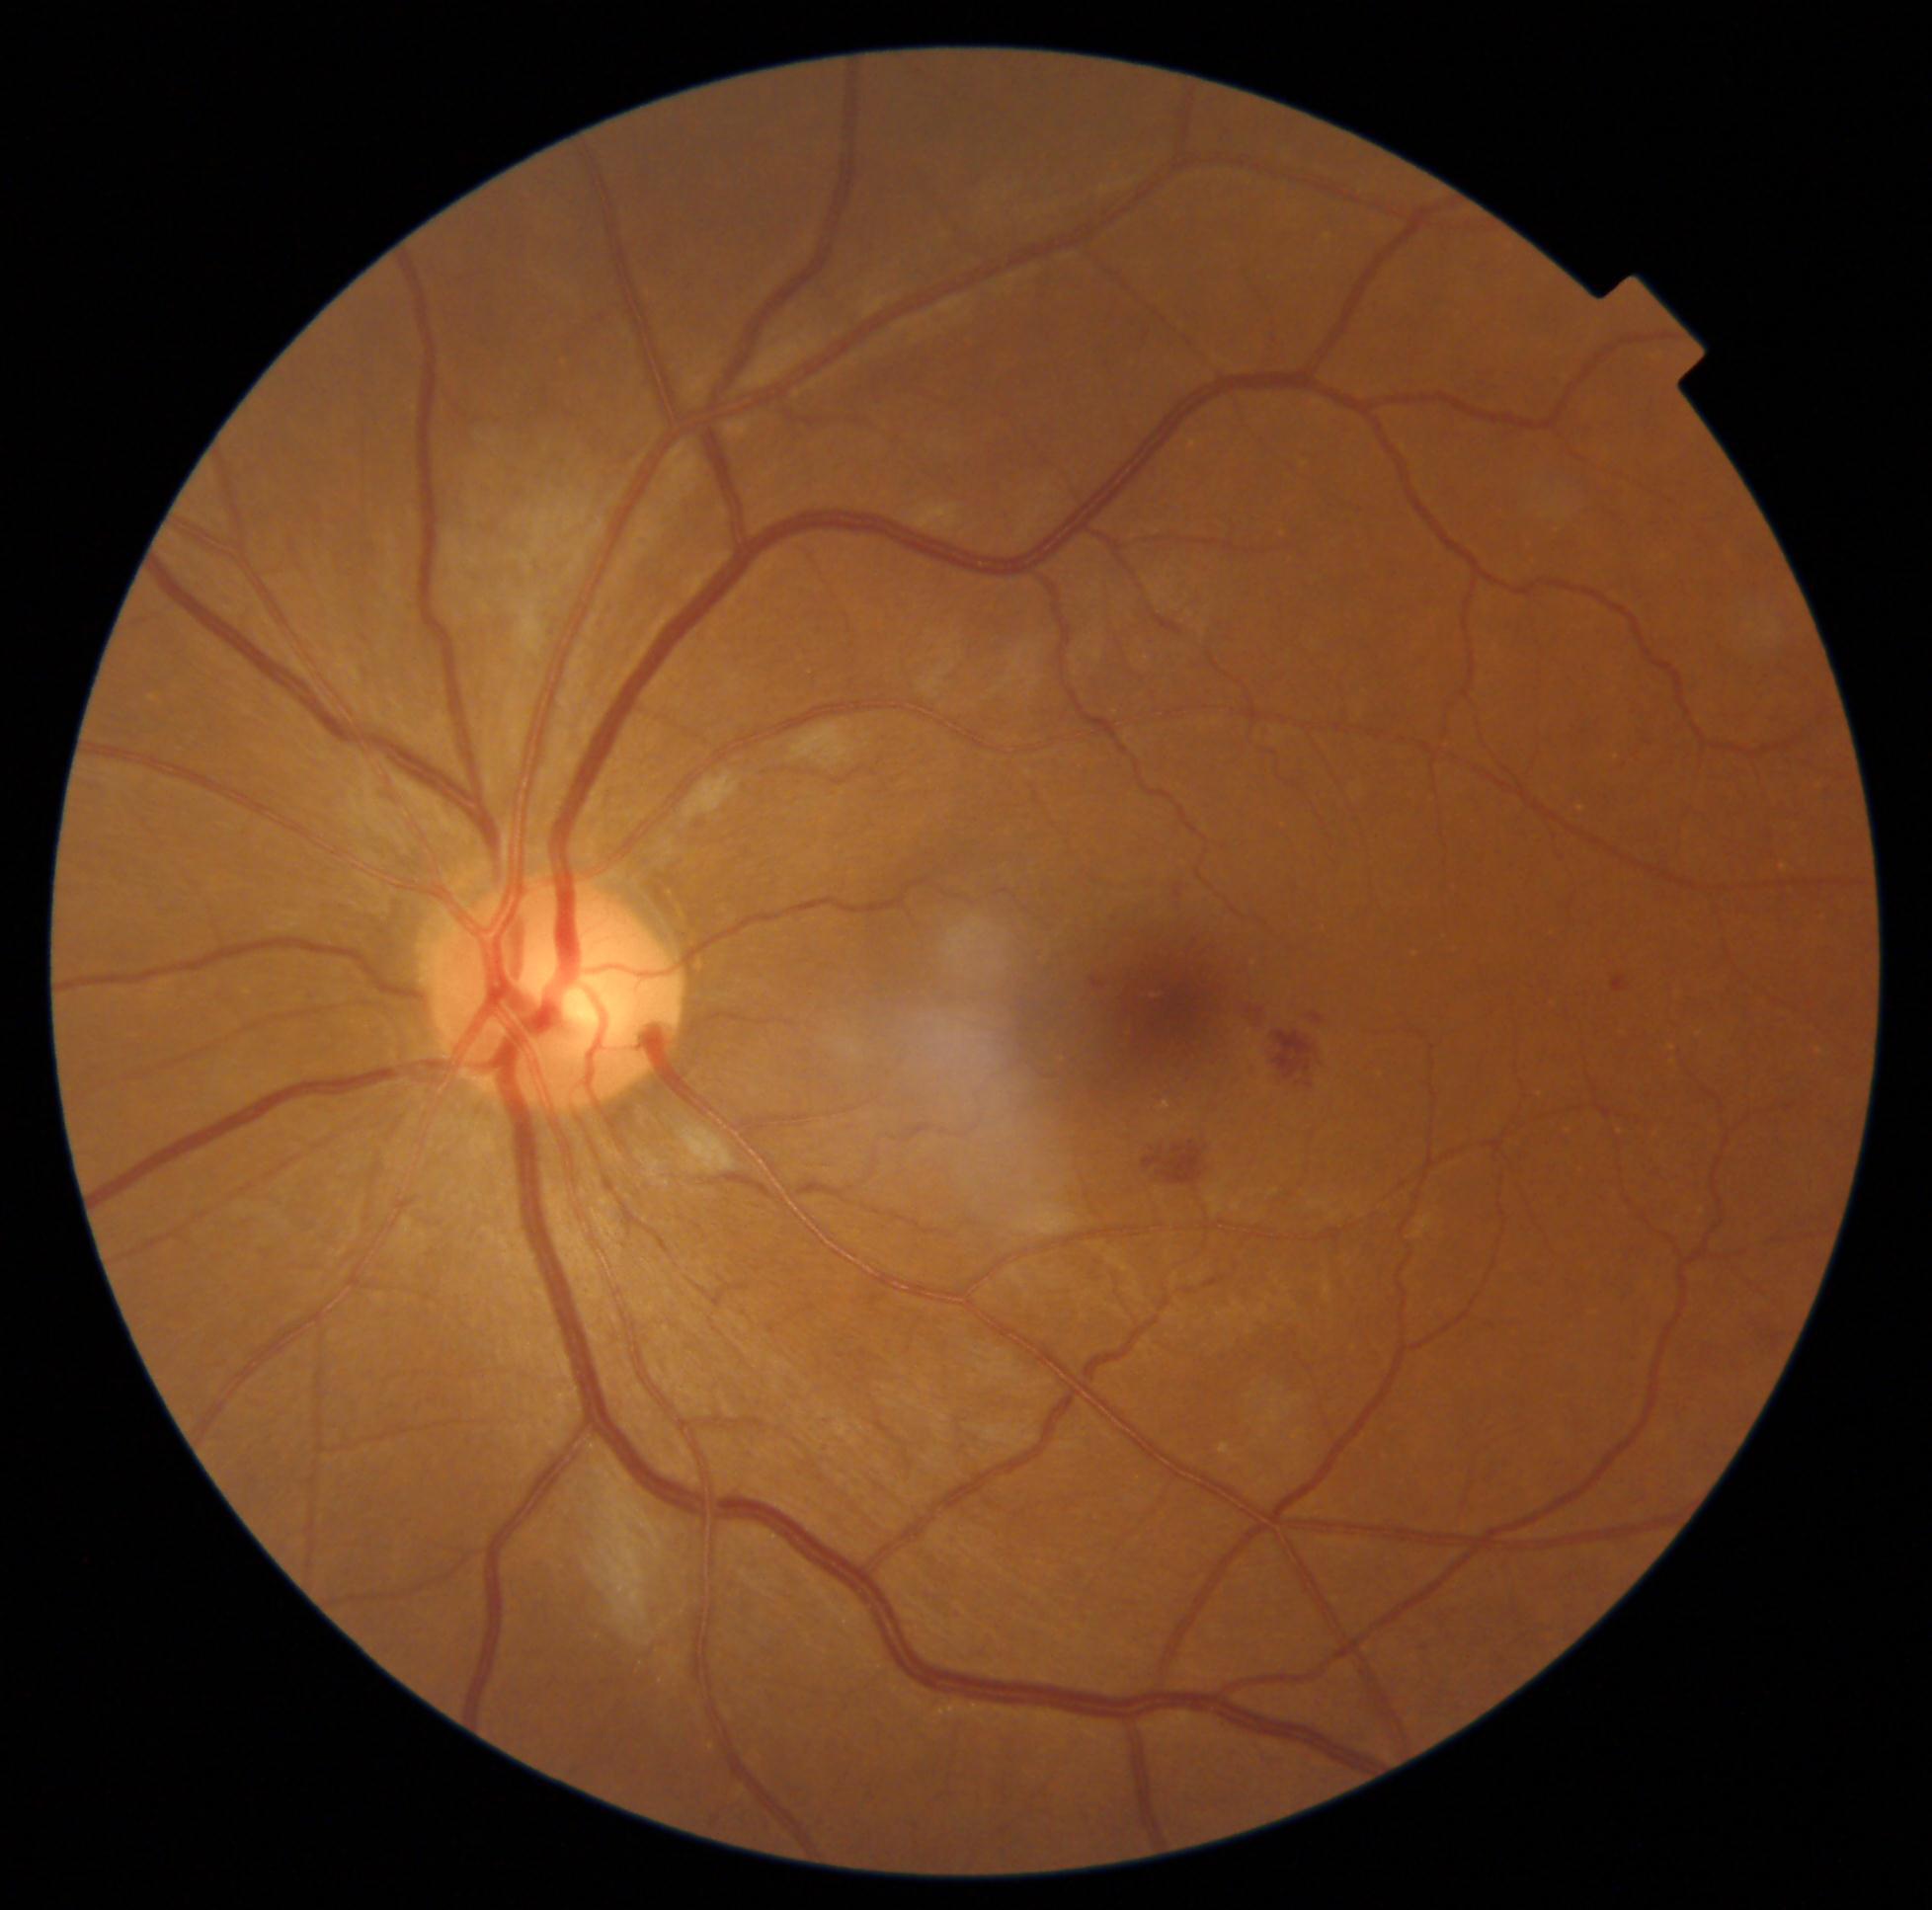
Diabetic retinopathy grade: moderate NPDR (2).